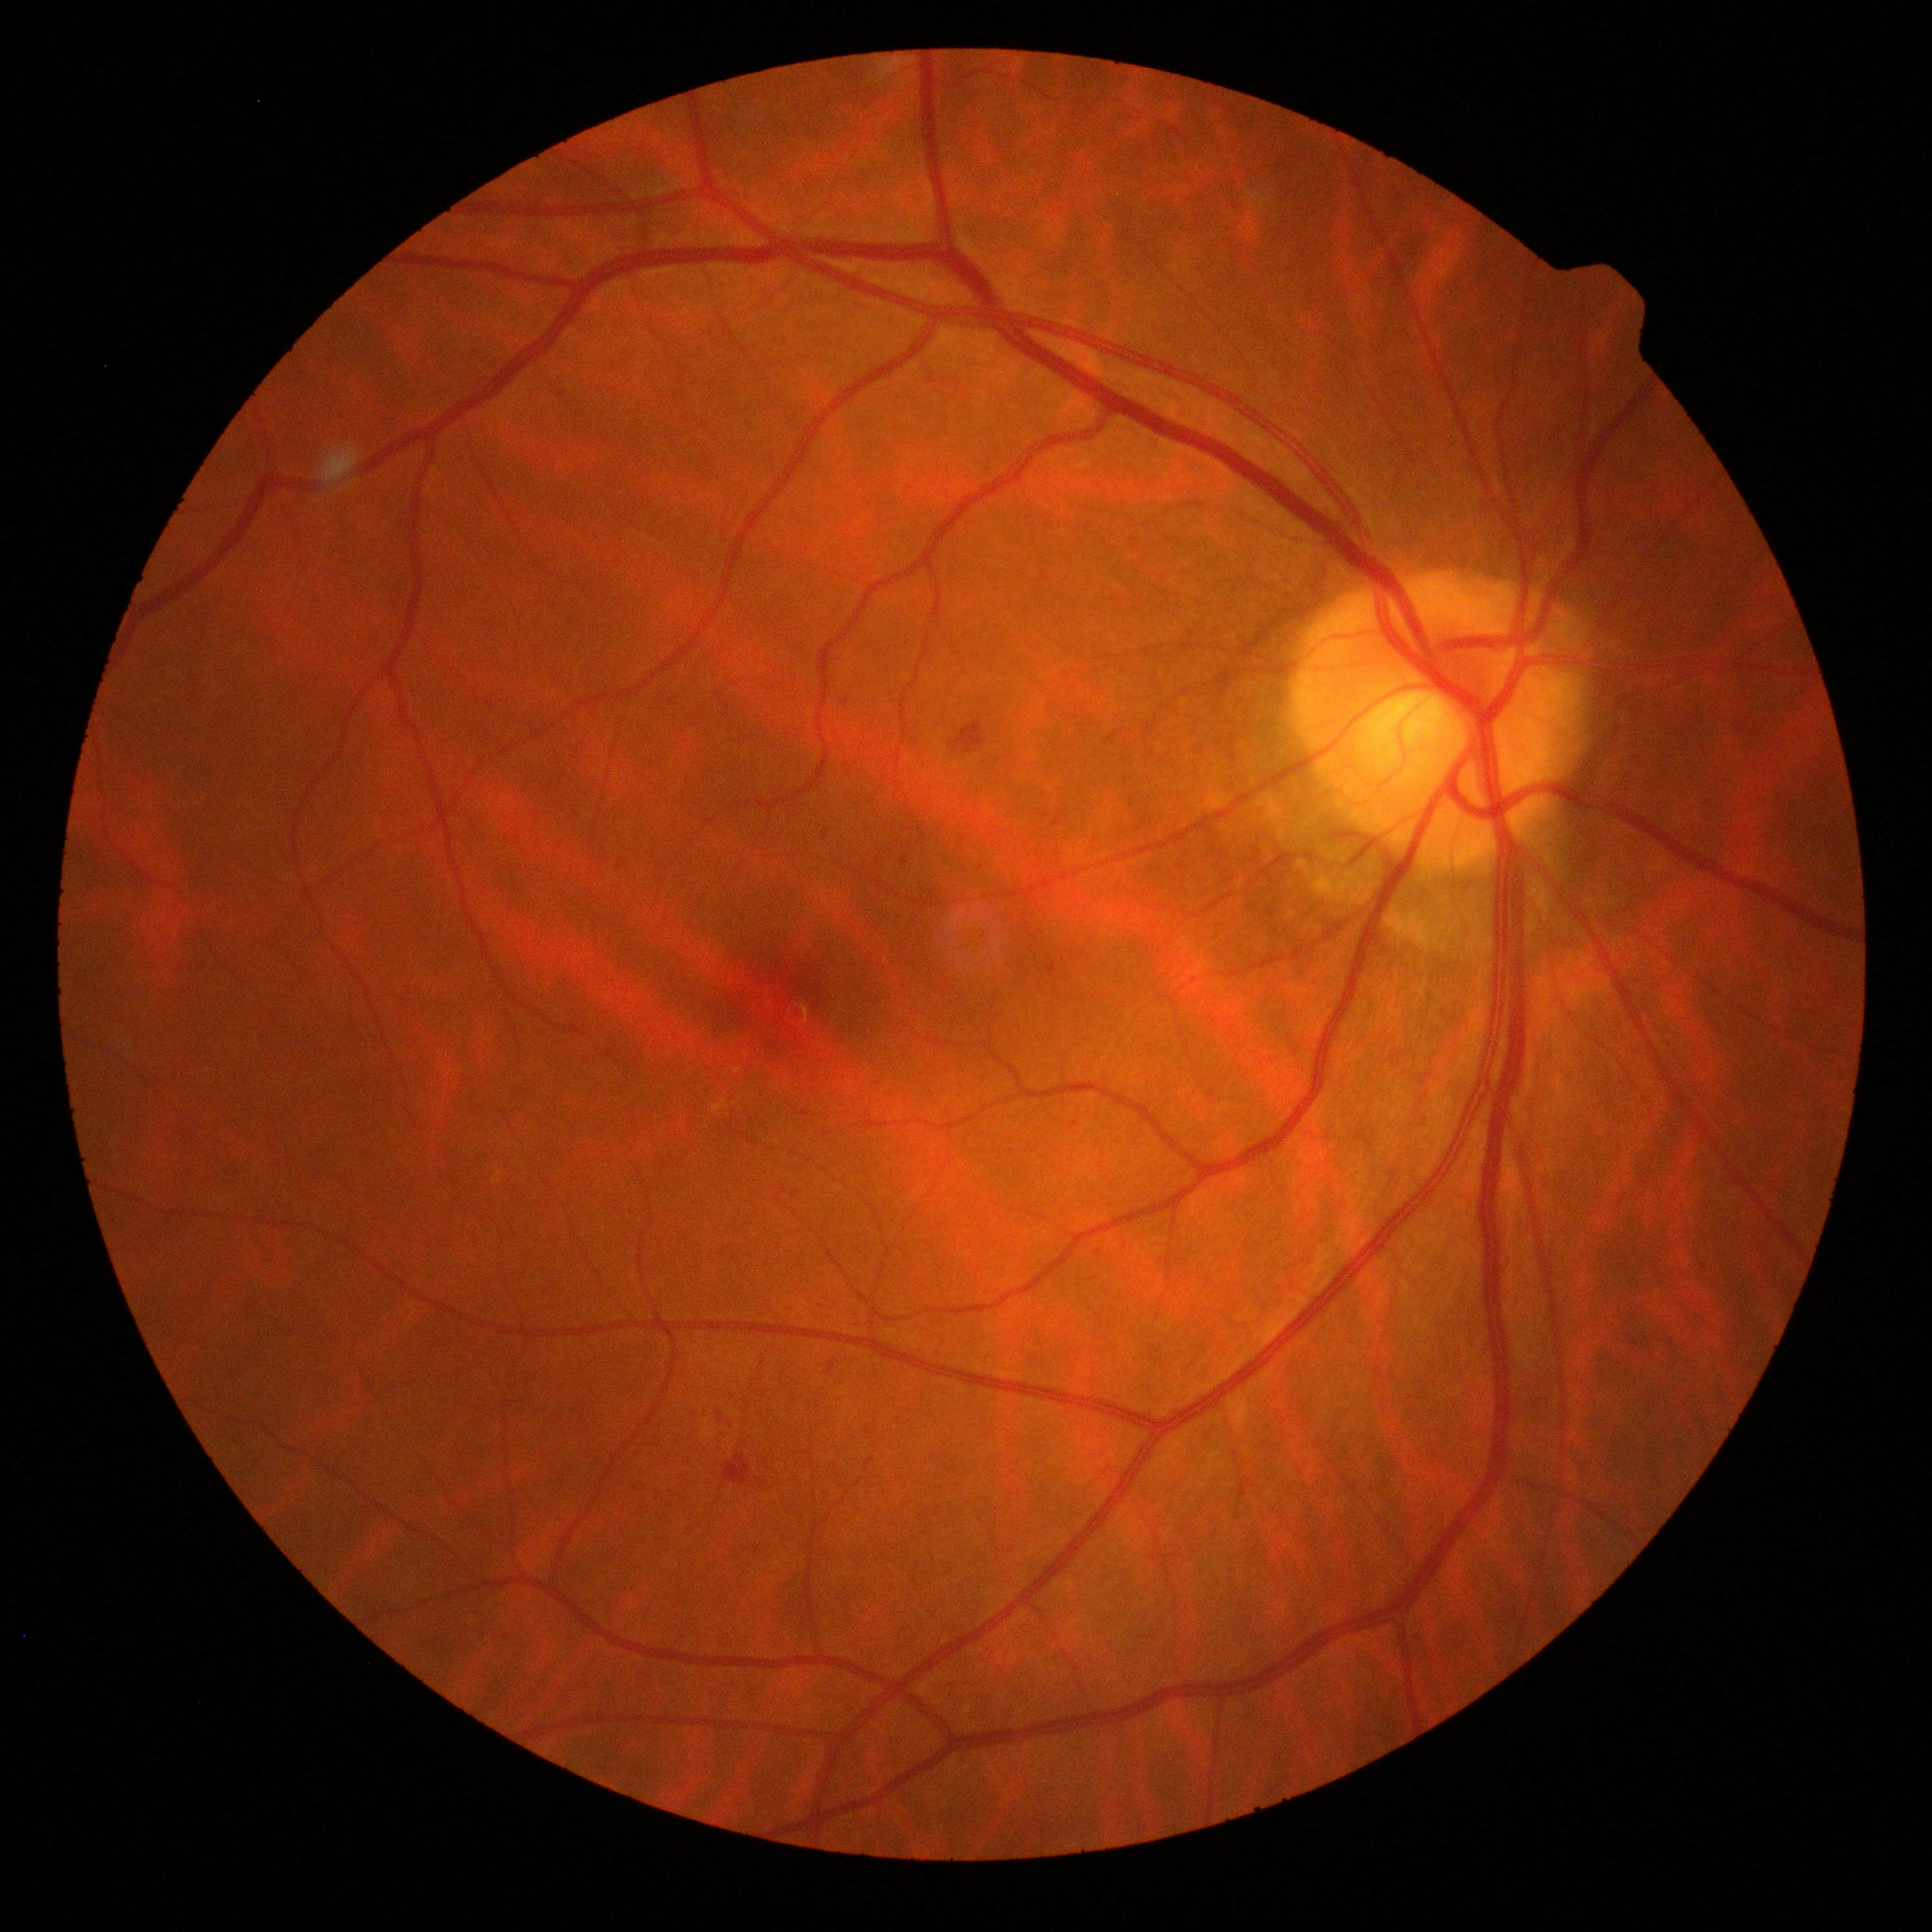

retinopathy: grade 2.